Wide-field fundus photograph of an infant — 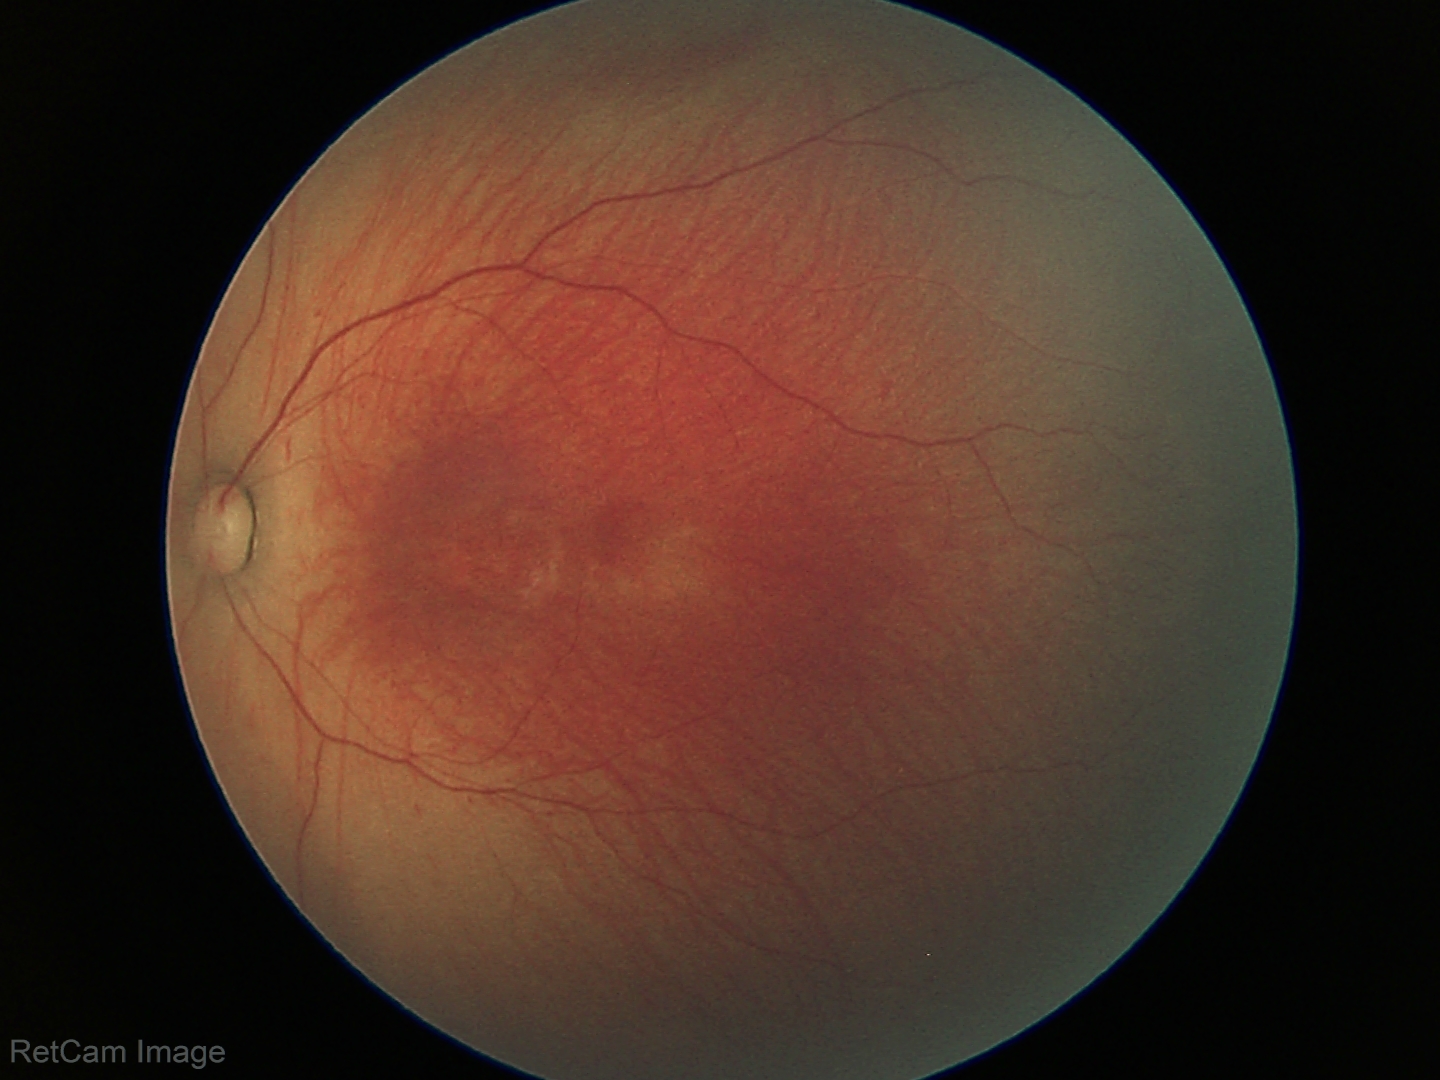 No plus disease. Examination diagnosed as retinopathy of prematurity (ROP) stage 1.